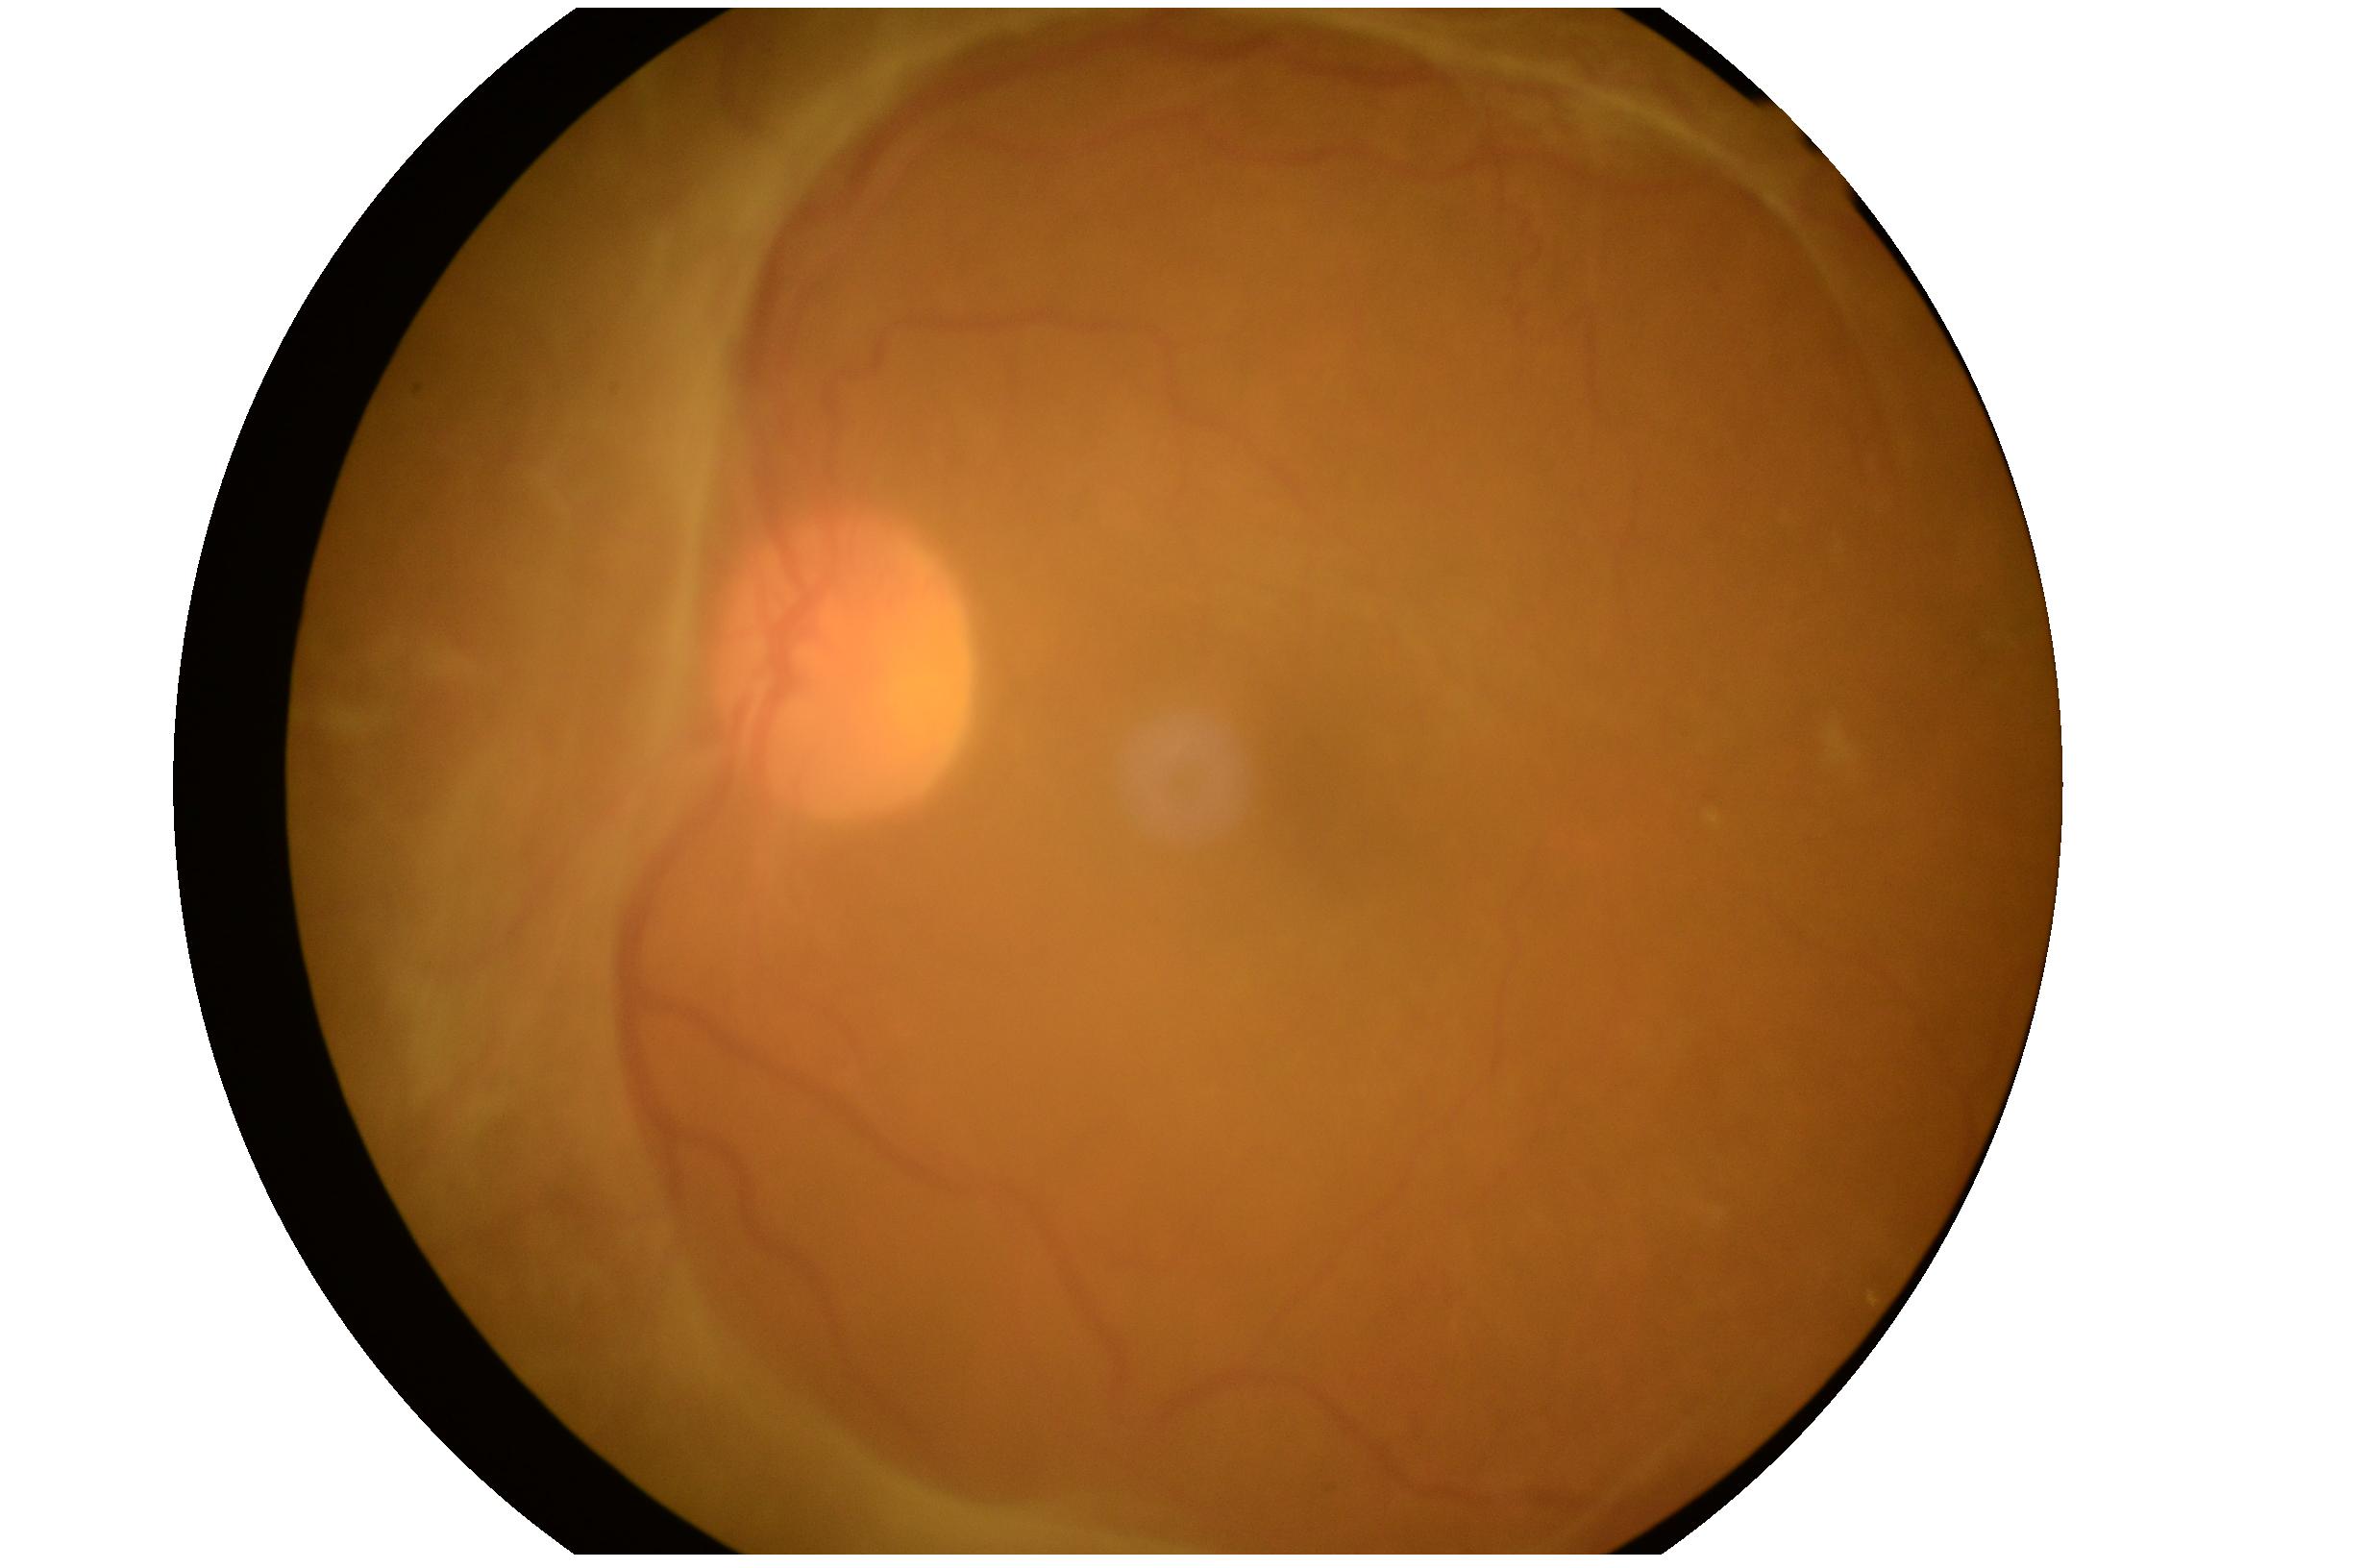 - diabetic retinopathy (DR): grade 4 (PDR)